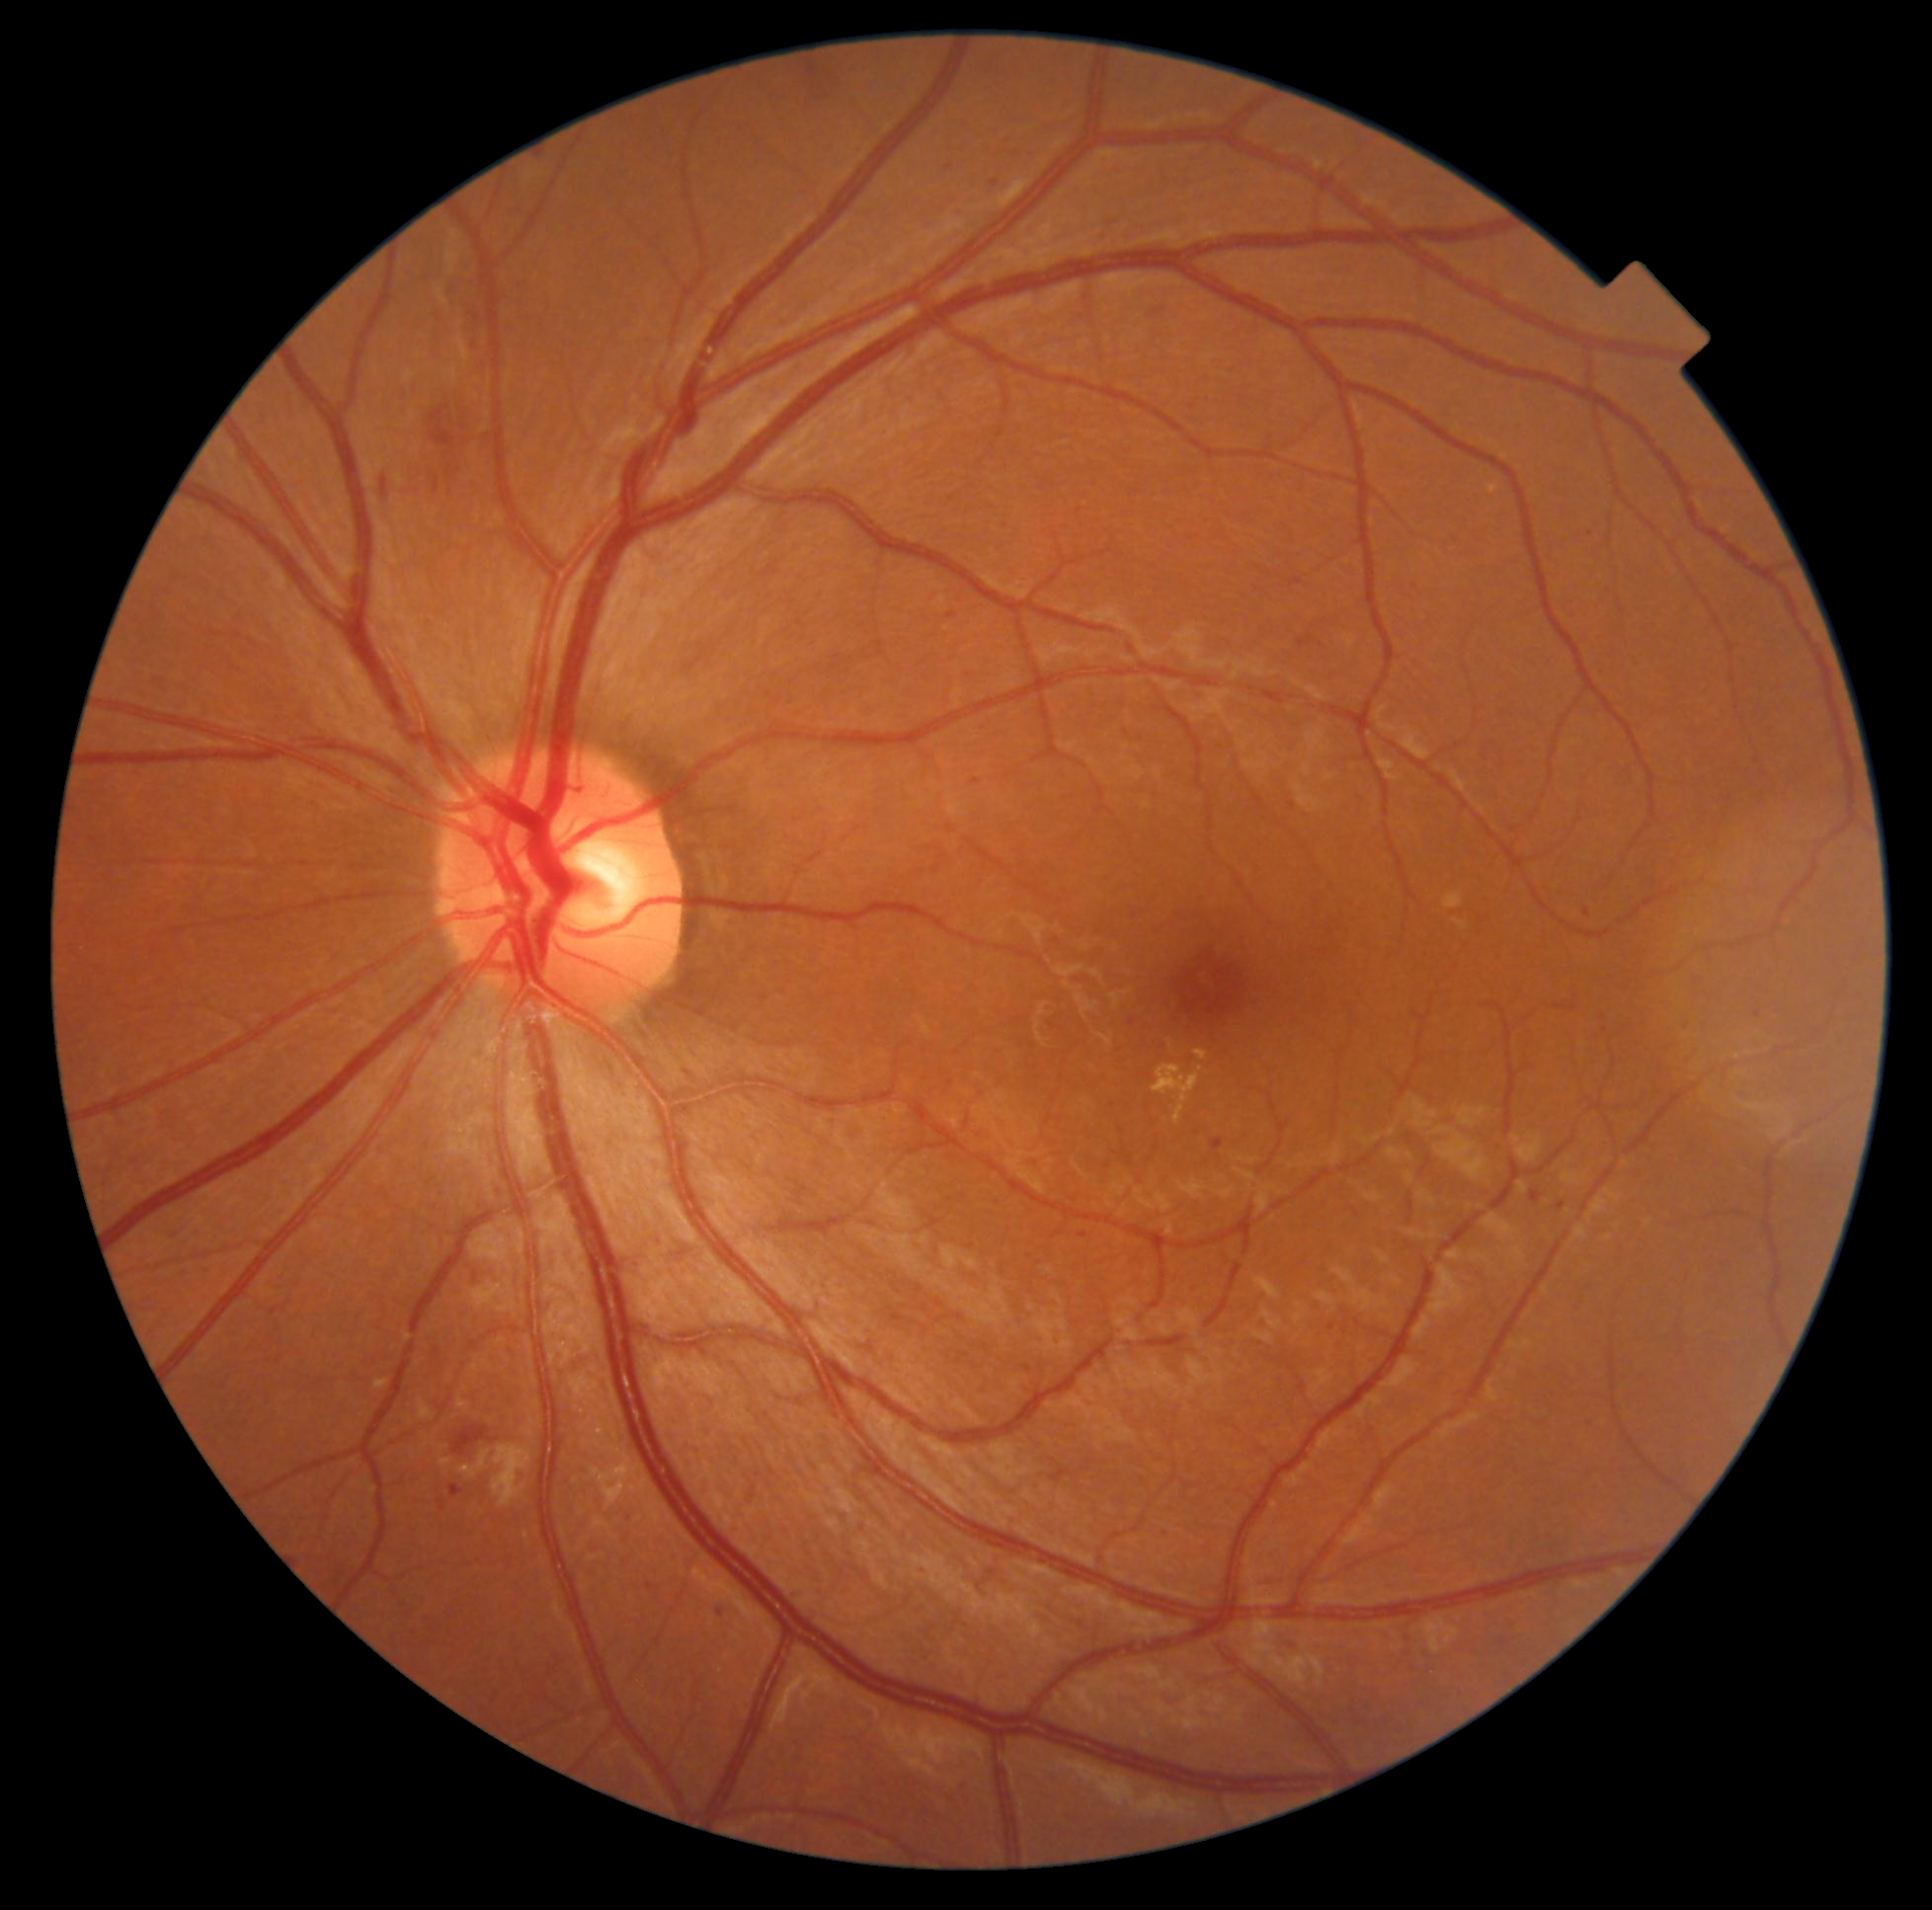 {"partial": true, "dr_grade": 2, "dr_grade_name": "moderate NPDR", "lesions": {"se": null, "ex": [[1154, 1066, 1204, 1126], [1195, 1051, 1209, 1062]], "he": [[454, 1426, 489, 1455], [430, 406, 456, 447], [435, 476, 441, 494], [381, 478, 388, 496]], "ma": [[972, 780, 981, 785], [441, 1503, 445, 1511], [1166, 1529, 1171, 1538], [1213, 1141, 1224, 1152], [451, 1485, 463, 1498], [947, 612, 957, 620], [913, 1564, 926, 1571]], "ma_small_approx": [[996, 183], [1591, 534], [1052, 1341], [688, 1074], [1587, 913], [474, 283]]}}